FOV: 45 degrees.
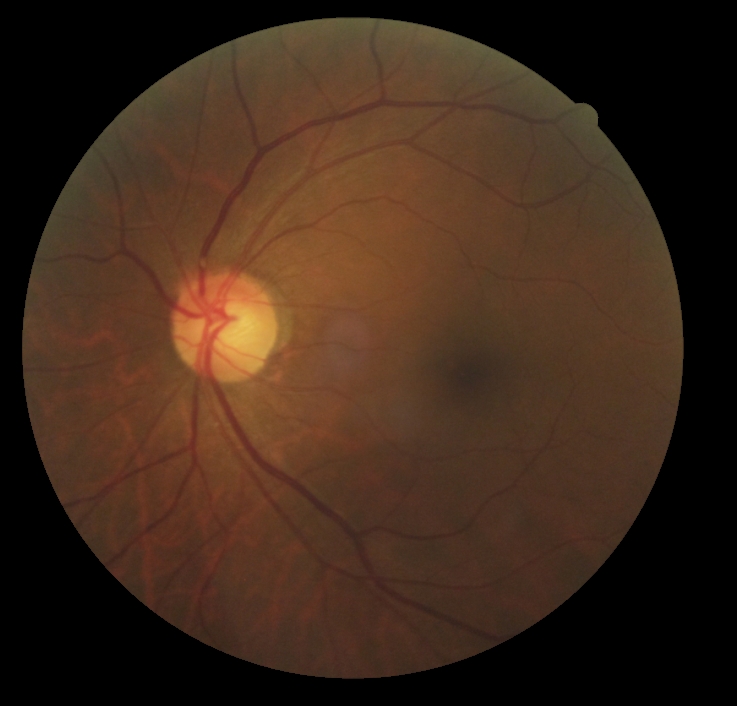 No diabetic retinal disease findings. Diabetic retinopathy (DR) is grade 0.